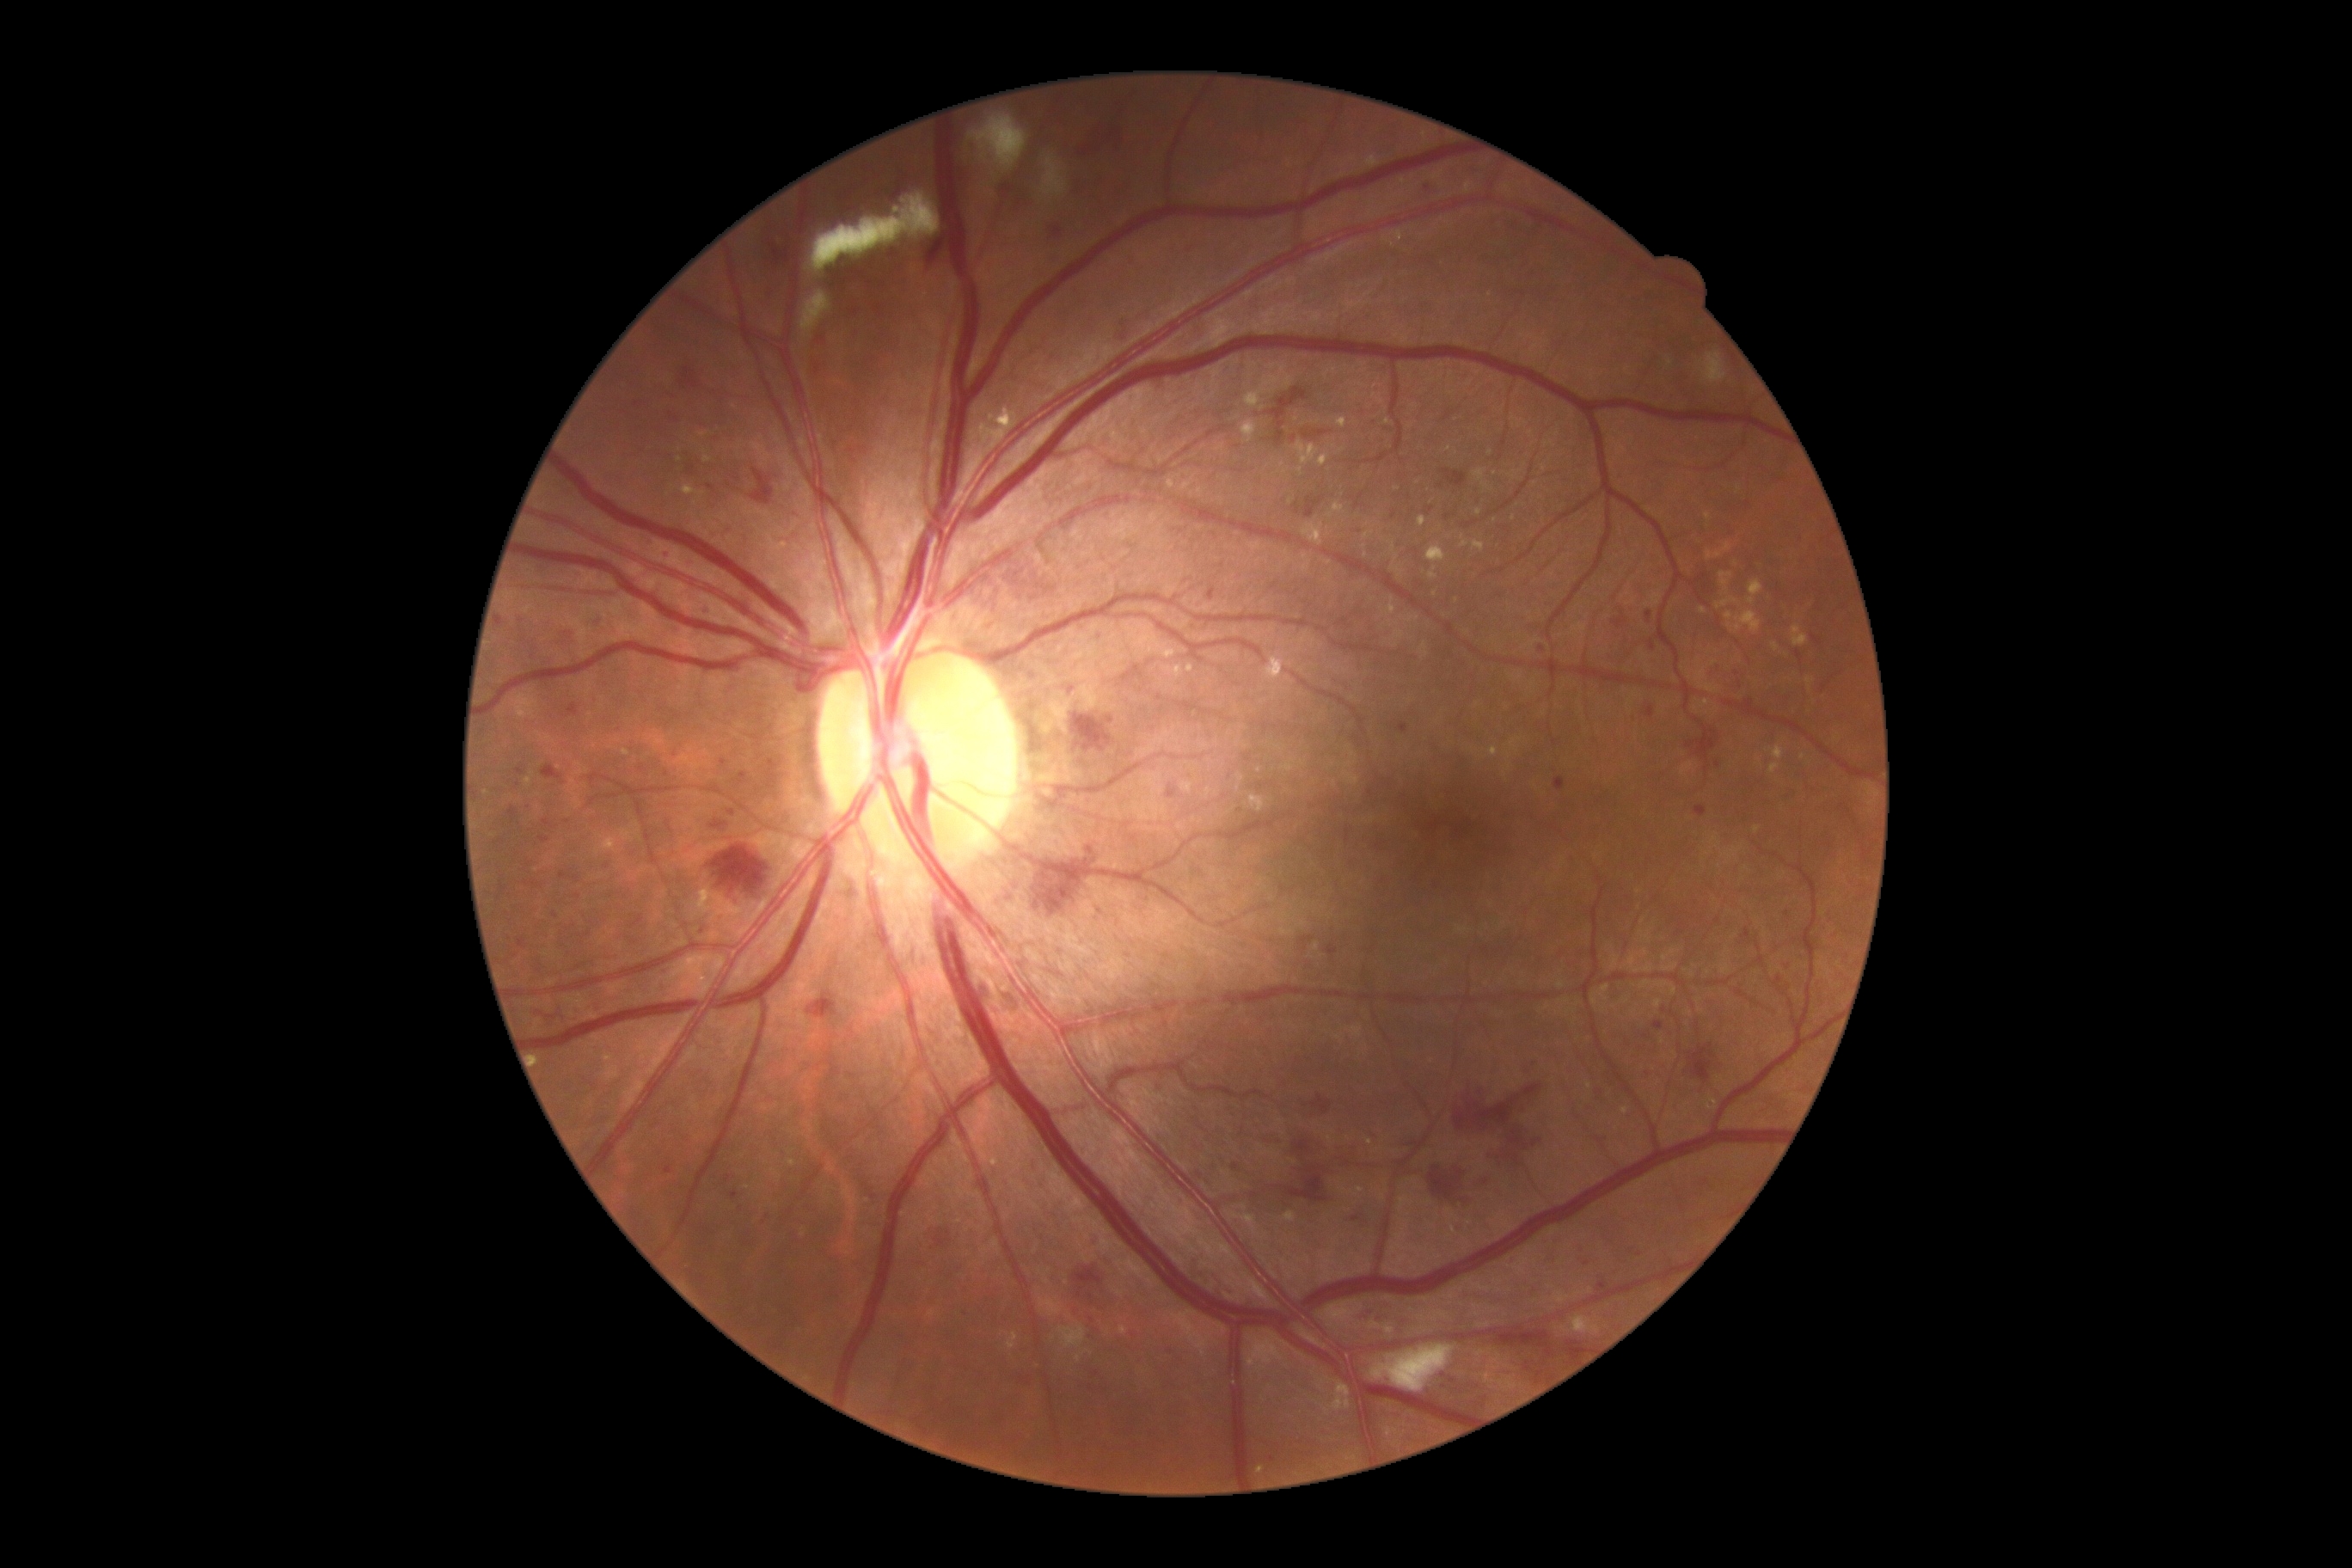
Retinopathy is grade 3 (severe NPDR)
Lesions identified (partial list):
• hard exudates (subset): x1=1725, y1=613, x2=1732, y2=630 | x1=1332, y1=1381, x2=1352, y2=1412 | x1=1718, y1=572, x2=1732, y2=596 | x1=1237, y1=775, x2=1244, y2=783 | x1=1180, y1=783, x2=1194, y2=793 | x1=1418, y1=517, x2=1426, y2=527 | x1=1706, y1=542, x2=1732, y2=561 | x1=1770, y1=747, x2=1785, y2=761 | x1=525, y1=778, x2=532, y2=788 | x1=604, y1=1065, x2=620, y2=1082
• Small hard exudates approximately at [x=803, y=1235] | [x=1339, y=1038] | [x=1589, y=1085] | [x=1397, y=489] | [x=707, y=459] | [x=1238, y=788] | [x=992, y=418]
• microaneurysms (subset): x1=1007, y1=897, x2=1015, y2=903 | x1=1775, y1=977, x2=1784, y2=986 | x1=934, y1=1230, x2=953, y2=1249 | x1=1295, y1=505, x2=1301, y2=515 | x1=1375, y1=1318, x2=1385, y2=1326 | x1=663, y1=971, x2=671, y2=977 | x1=1069, y1=689, x2=1081, y2=697 | x1=1357, y1=1311, x2=1371, y2=1321 | x1=1810, y1=635, x2=1822, y2=646 | x1=1299, y1=936, x2=1314, y2=950 | x1=1743, y1=699, x2=1755, y2=706
• Small microaneurysms approximately at [x=1394, y=515] | [x=1484, y=951] | [x=588, y=935] | [x=677, y=420] | [x=1706, y=770] | [x=642, y=769] | [x=568, y=633] | [x=1077, y=1313]